Color fundus image, 45° FOV, image size 2048x1536:
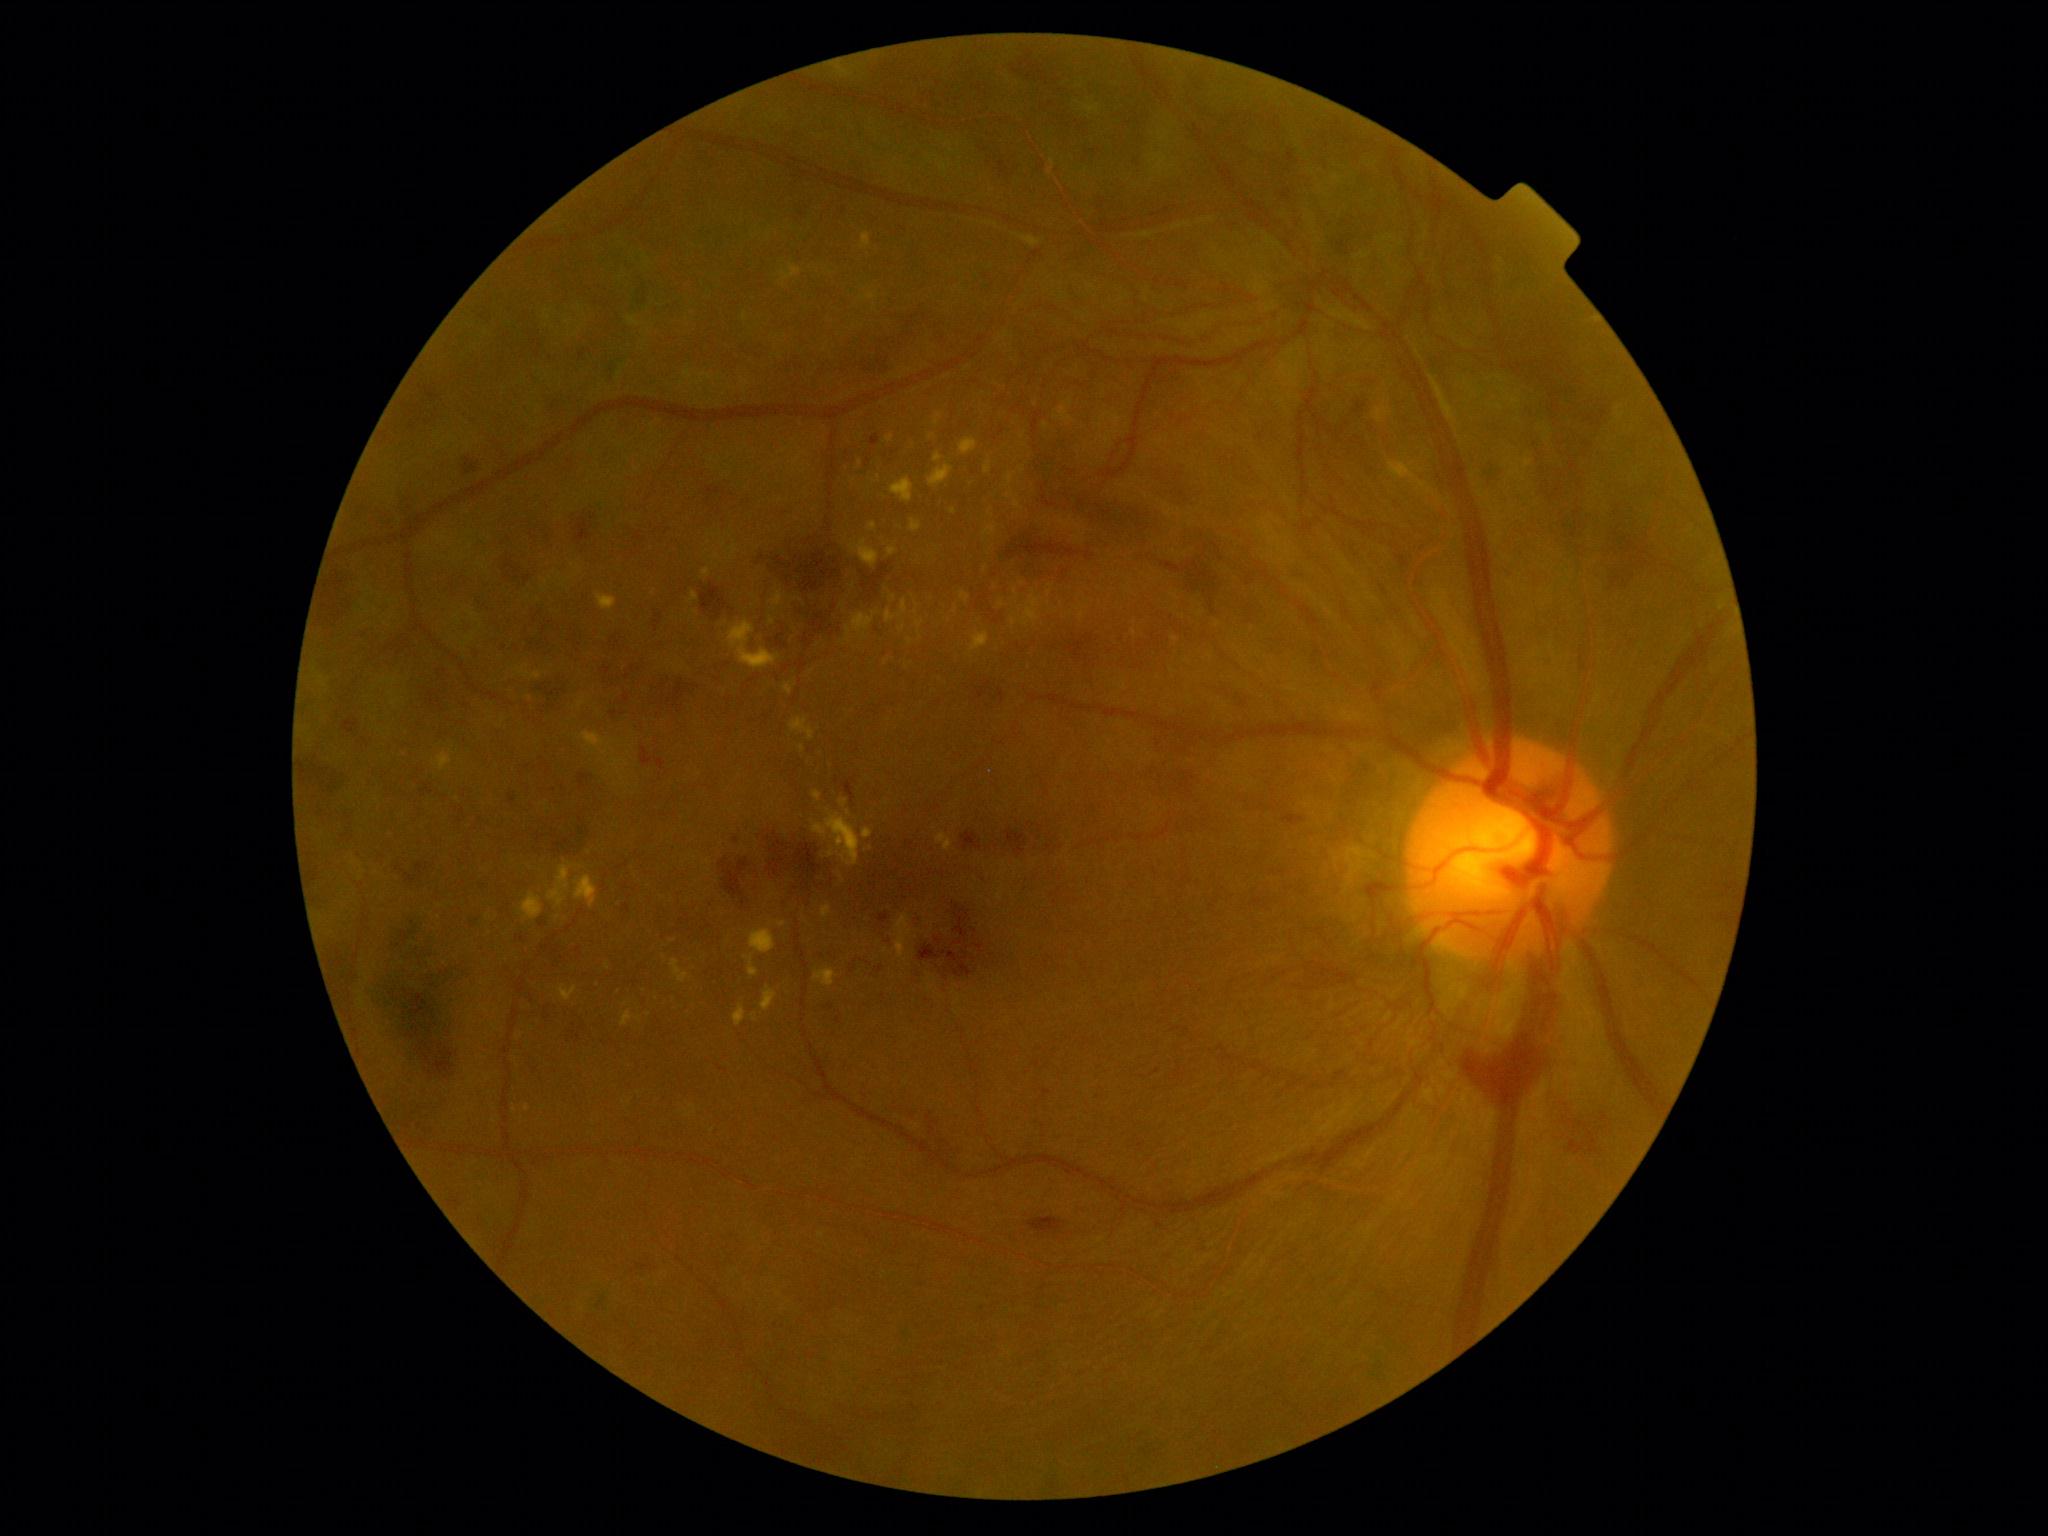 Diabetic retinopathy (DR): 4/4; proliferative diabetic retinopathy.
Hemorrhages (HEs) (partial list) at [x1=502, y1=556, x2=534, y2=587]; [x1=999, y1=531, x2=1100, y2=580]; [x1=1602, y1=520, x2=1651, y2=593]; [x1=654, y1=611, x2=663, y2=632]; [x1=720, y1=858, x2=751, y2=899]; [x1=971, y1=132, x2=1018, y2=188]; [x1=1028, y1=1217, x2=1067, y2=1234]; [x1=1484, y1=461, x2=1499, y2=487]; [x1=575, y1=518, x2=594, y2=546]; [x1=366, y1=915, x2=474, y2=1083]; [x1=1458, y1=1027, x2=1552, y2=1117]; [x1=803, y1=636, x2=812, y2=647]; [x1=1559, y1=1117, x2=1604, y2=1160]; [x1=539, y1=826, x2=590, y2=856]; [x1=601, y1=664, x2=635, y2=690].
No soft exudates (SEs) identified.
Hard exudates (EXs) (partial list) at [x1=890, y1=478, x2=913, y2=503]; [x1=753, y1=1013, x2=757, y2=1022]; [x1=984, y1=527, x2=996, y2=537]; [x1=621, y1=1011, x2=634, y2=1027]; [x1=516, y1=666, x2=542, y2=680]; [x1=1014, y1=501, x2=1021, y2=510]; [x1=703, y1=568, x2=711, y2=577]; [x1=1018, y1=592, x2=1041, y2=626]; [x1=558, y1=985, x2=578, y2=1001]; [x1=910, y1=520, x2=922, y2=533]; [x1=888, y1=547, x2=898, y2=557]; [x1=812, y1=809, x2=860, y2=866].
EXs (small, approximate centers) near <pt>717,556</pt>; <pt>853,586</pt>; <pt>1082,616</pt>; <pt>871,848</pt>; <pt>581,705</pt>; <pt>559,917</pt>; <pt>640,1019</pt>; <pt>1023,436</pt>.
Microaneurysms (MAs) (partial list) at [x1=1366, y1=420, x2=1379, y2=433]; [x1=1247, y1=576, x2=1254, y2=586]; [x1=1299, y1=607, x2=1320, y2=626]; [x1=878, y1=914, x2=889, y2=924]; [x1=1726, y1=883, x2=1739, y2=894]; [x1=438, y1=700, x2=443, y2=710]; [x1=1314, y1=646, x2=1324, y2=659]; [x1=624, y1=905, x2=631, y2=913]; [x1=1261, y1=571, x2=1270, y2=580]; [x1=1289, y1=150, x2=1294, y2=162]; [x1=594, y1=1299, x2=607, y2=1314]; [x1=843, y1=779, x2=856, y2=803].
MAs (small, approximate centers) near <pt>1160,1226</pt>; <pt>532,1000</pt>; <pt>802,215</pt>; <pt>869,964</pt>.